848 x 848 pixels.
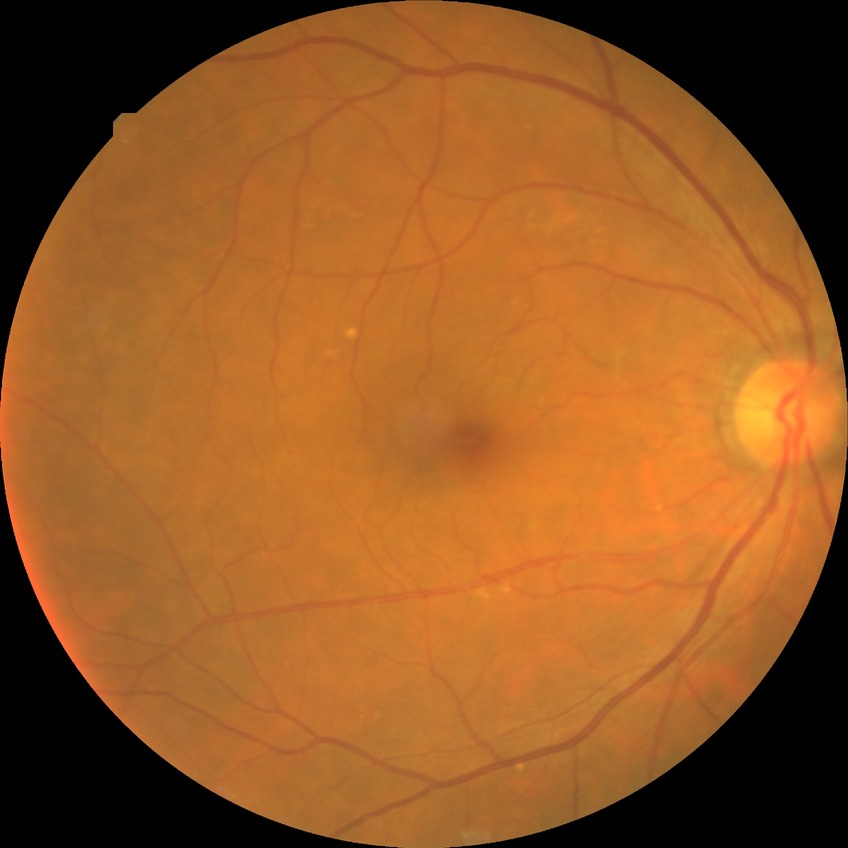
modified Davis classification = no diabetic retinopathy.